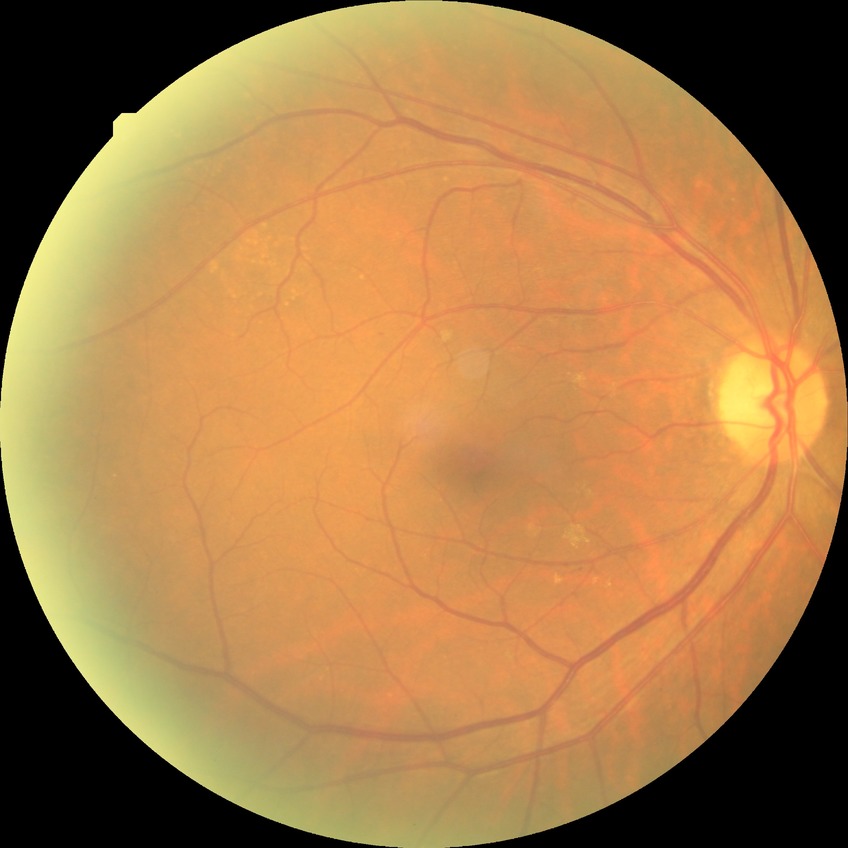

DR: SDR.